Pediatric wide-field fundus photograph: 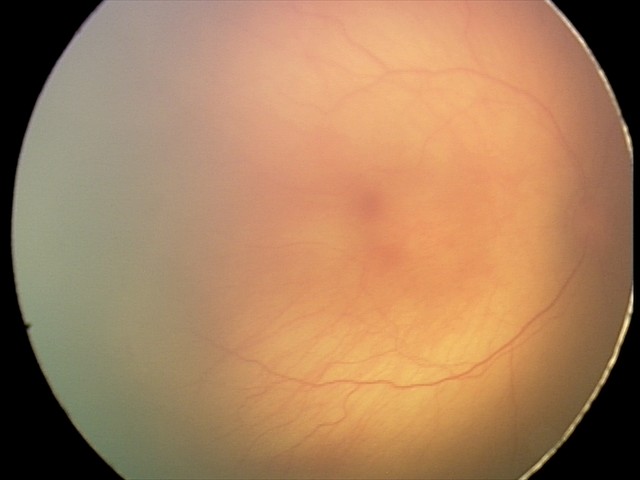 Plus form = absent; retinopathy of prematurity (ROP) = stage 1.